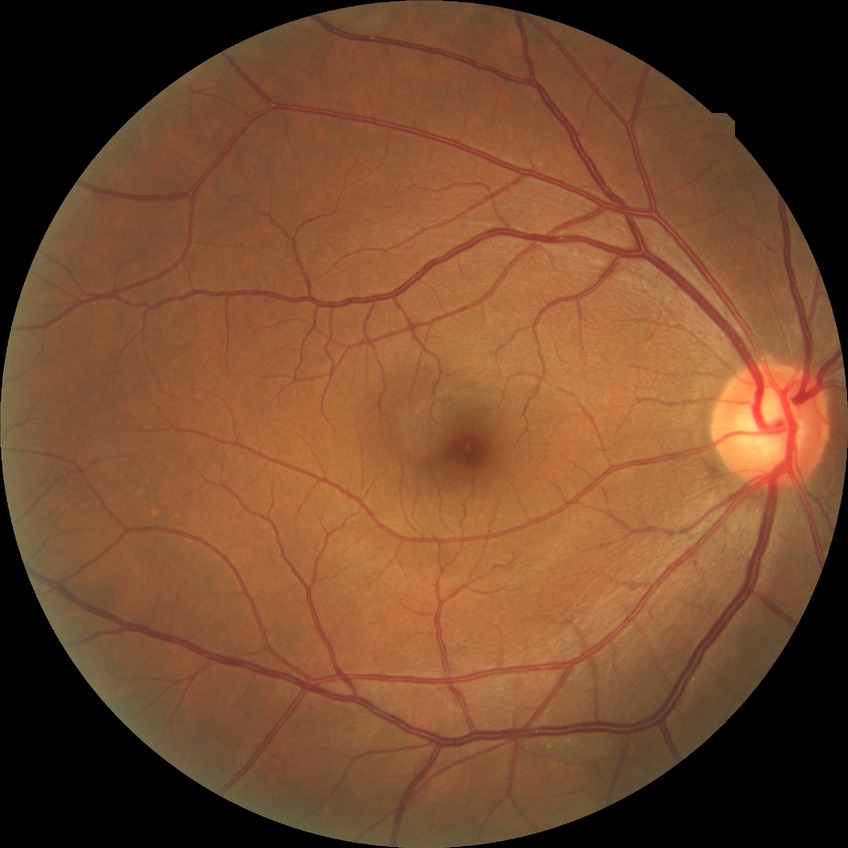

Diabetic retinopathy (DR) is no diabetic retinopathy (NDR).